45° FOV
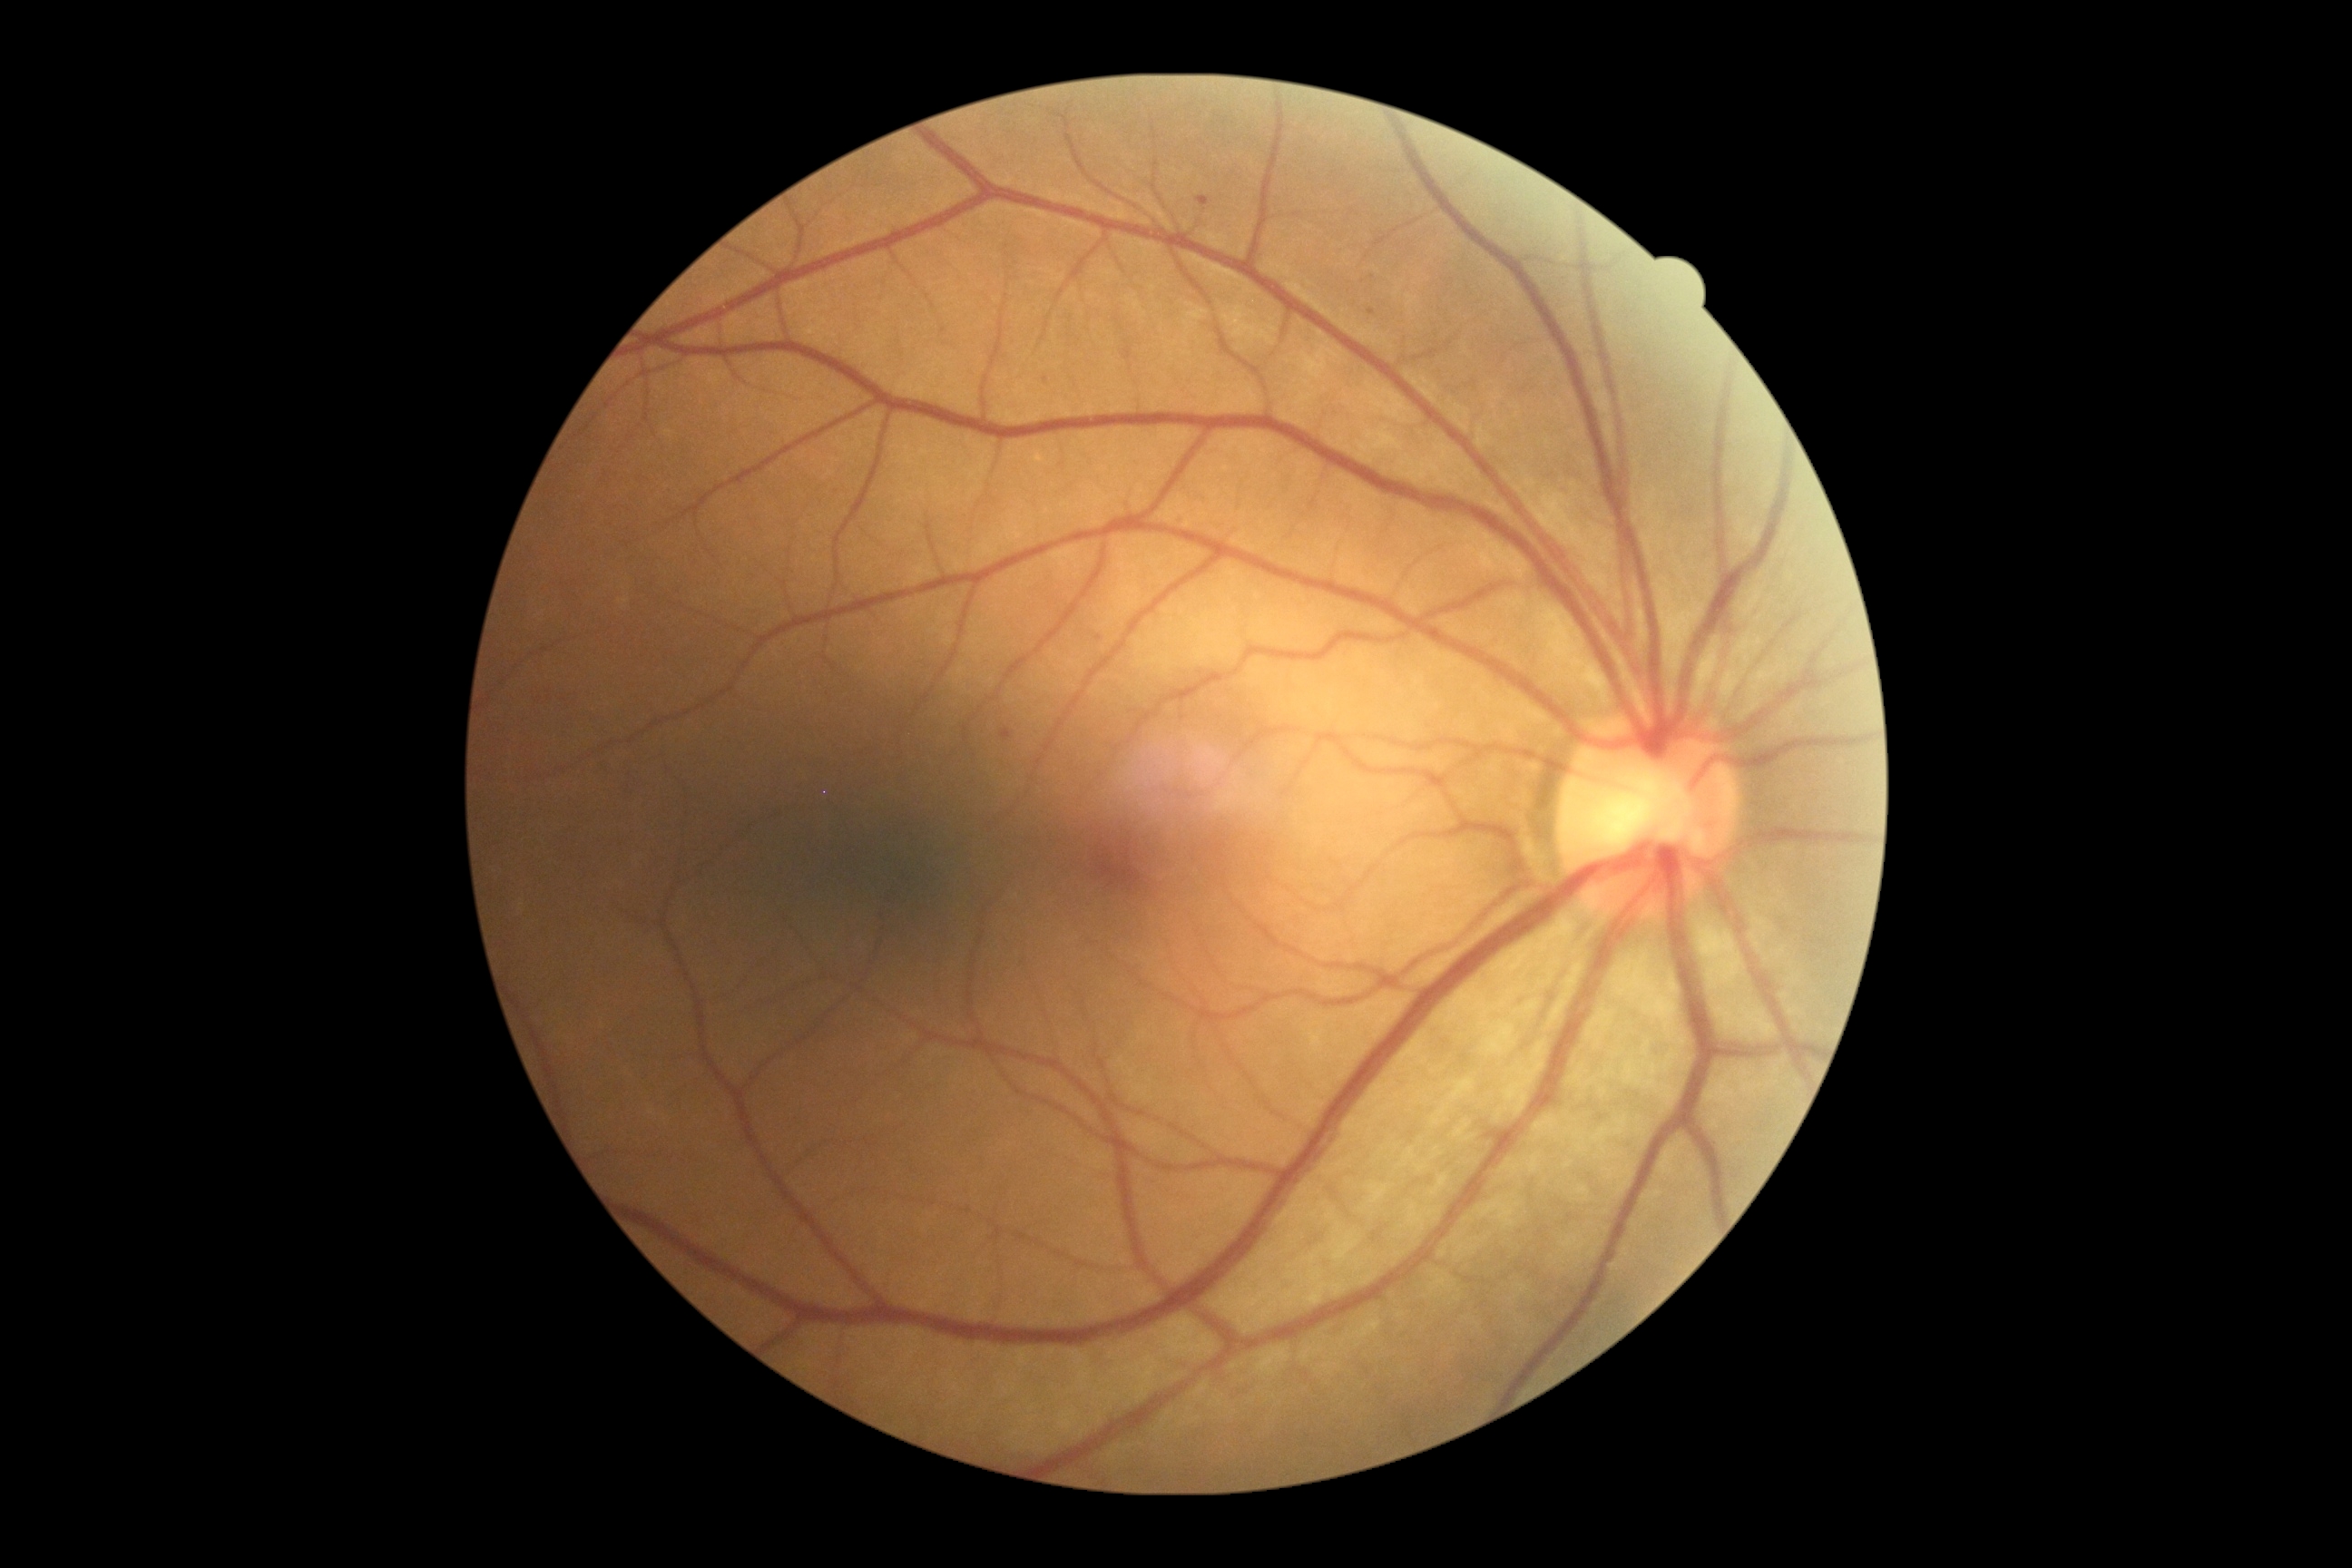
dr_grade: 1
dr_grade_name: mild NPDR
lesions:
  ex: []
  se: []
  he: []
  ma:
    - [left=1001, top=729, right=1012, bottom=741]
    - [left=1197, top=195, right=1210, bottom=208]
    - [left=1369, top=309, right=1375, bottom=317]
  ma_small_approx:
    - 1099, 638